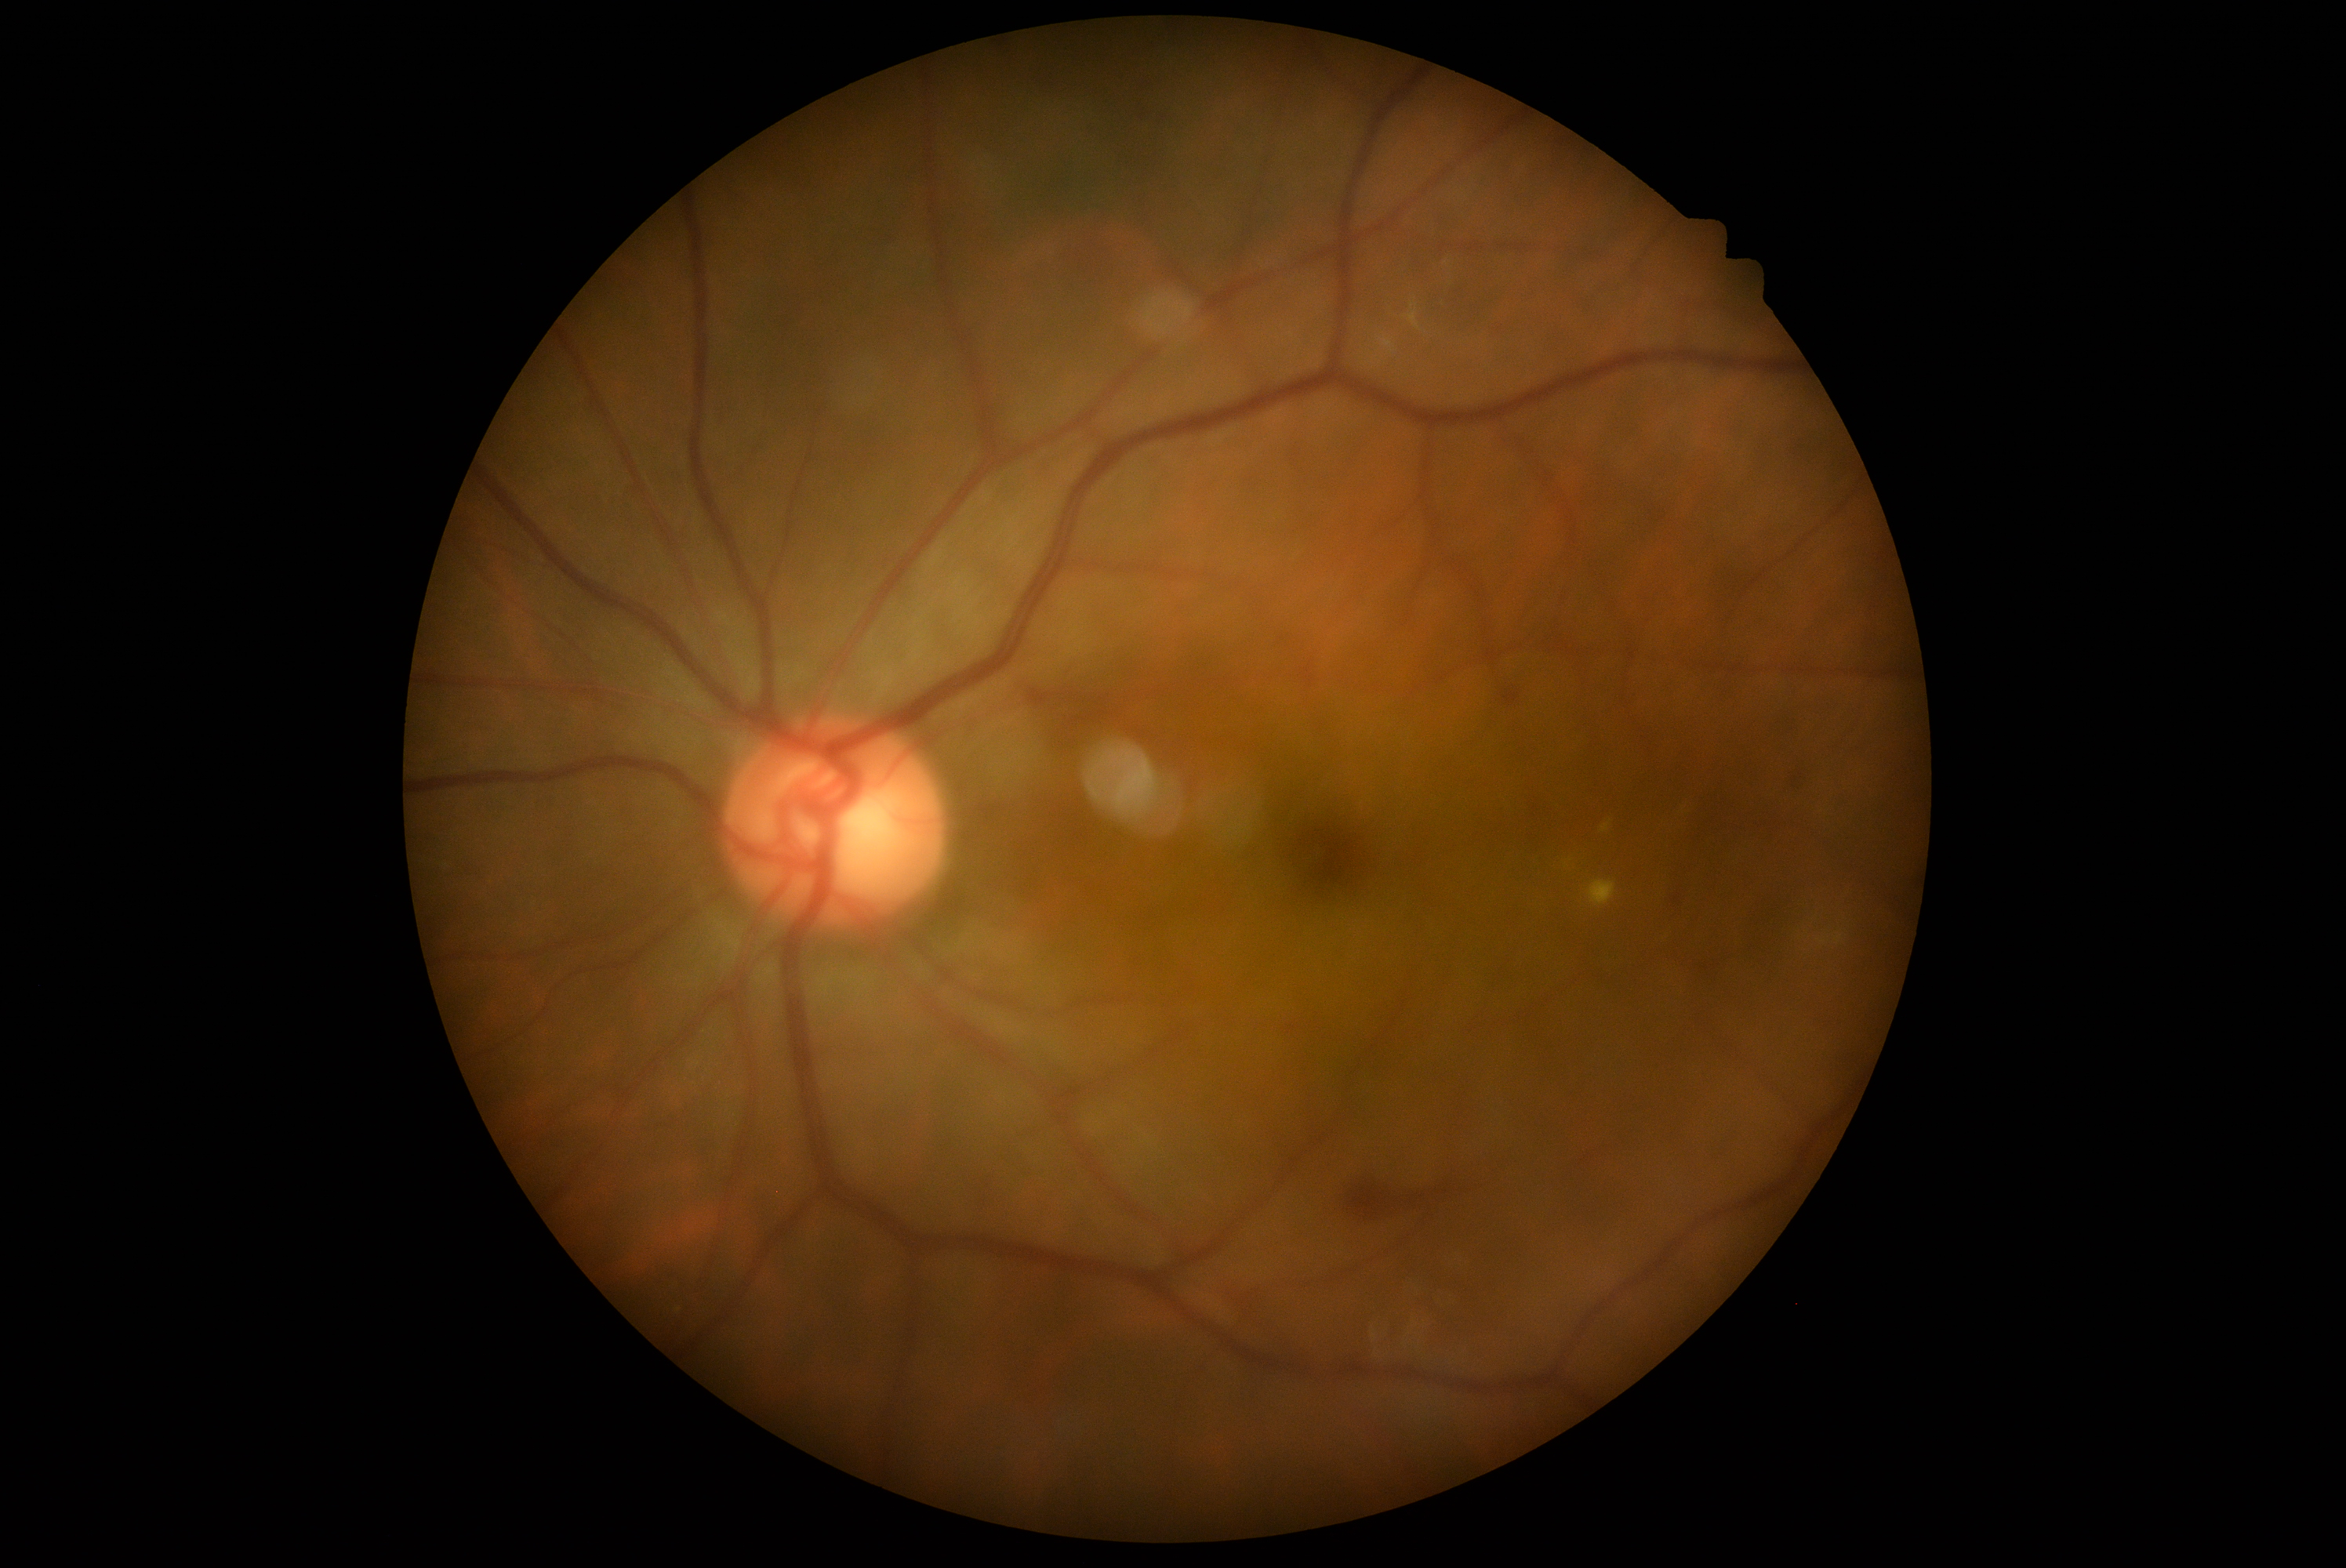
DR stage: grade 2 (moderate NPDR) — more than just microaneurysms but less than severe NPDR.